Wide-field fundus photograph of an infant; 1240x1240px; camera: Phoenix ICON (100° FOV):
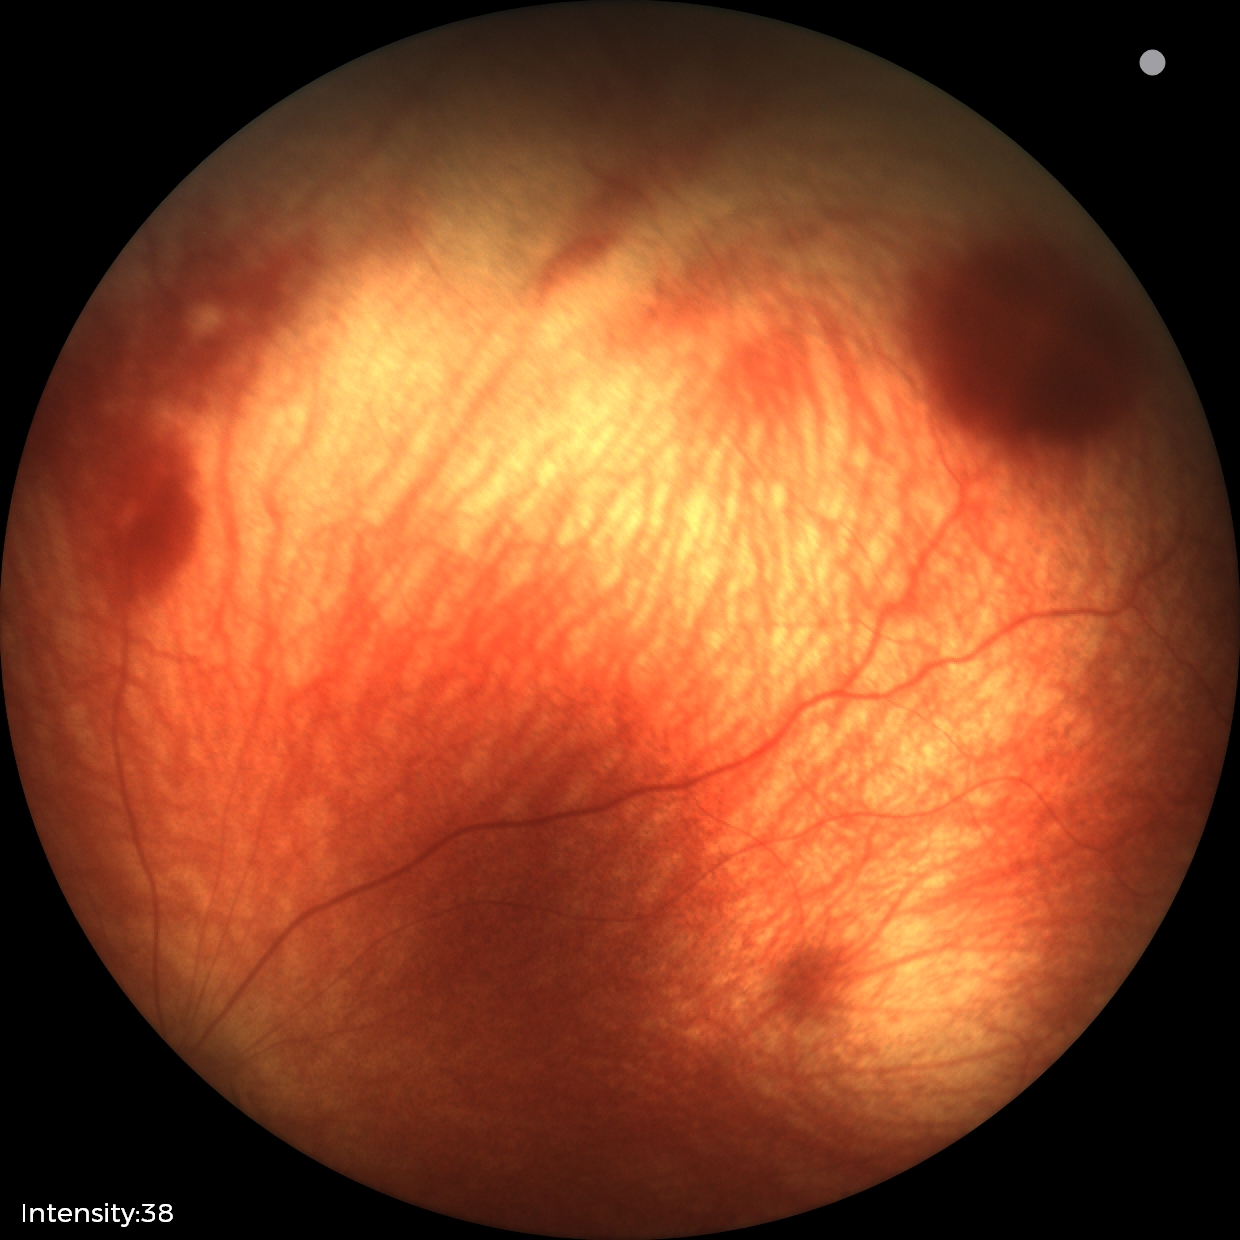

From an examination with diagnosis of retinal hemorrhages.